2352 by 1568 pixels · fundus photo · 45° field of view: 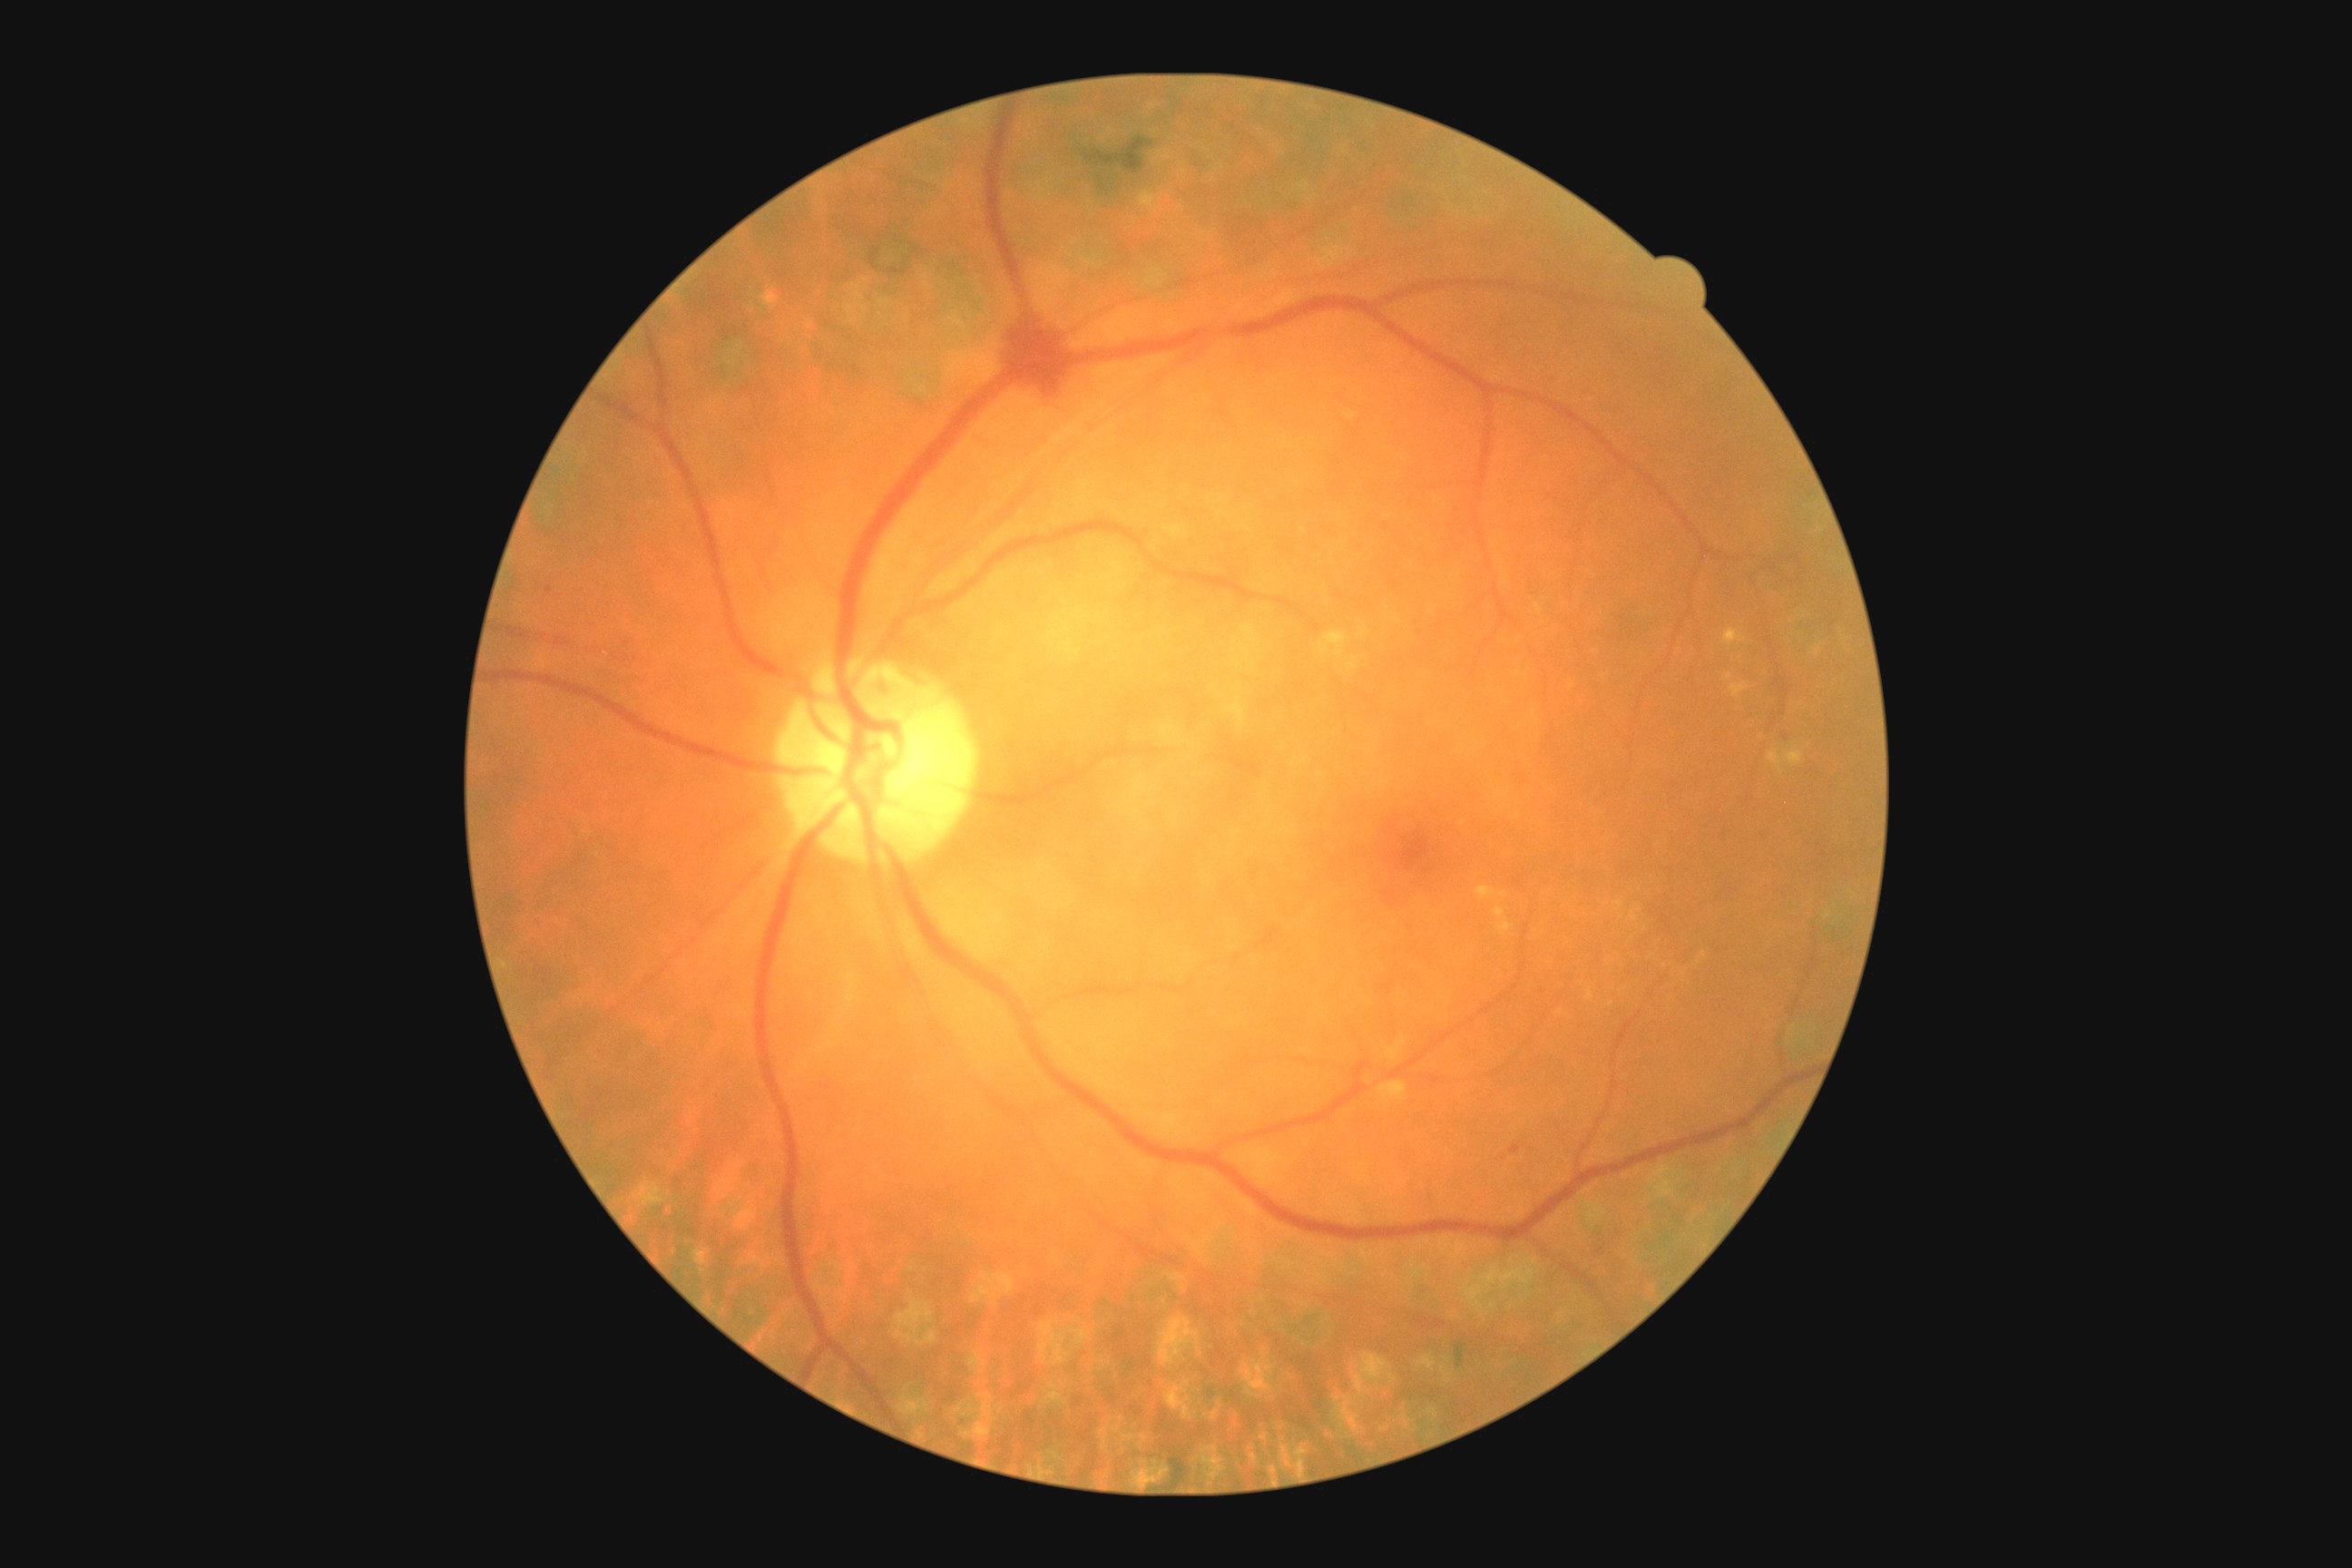 retinopathy = grade 2 (moderate NPDR)
DR class = non-proliferative diabetic retinopathy